Image size 2352x1568, 45° FOV — 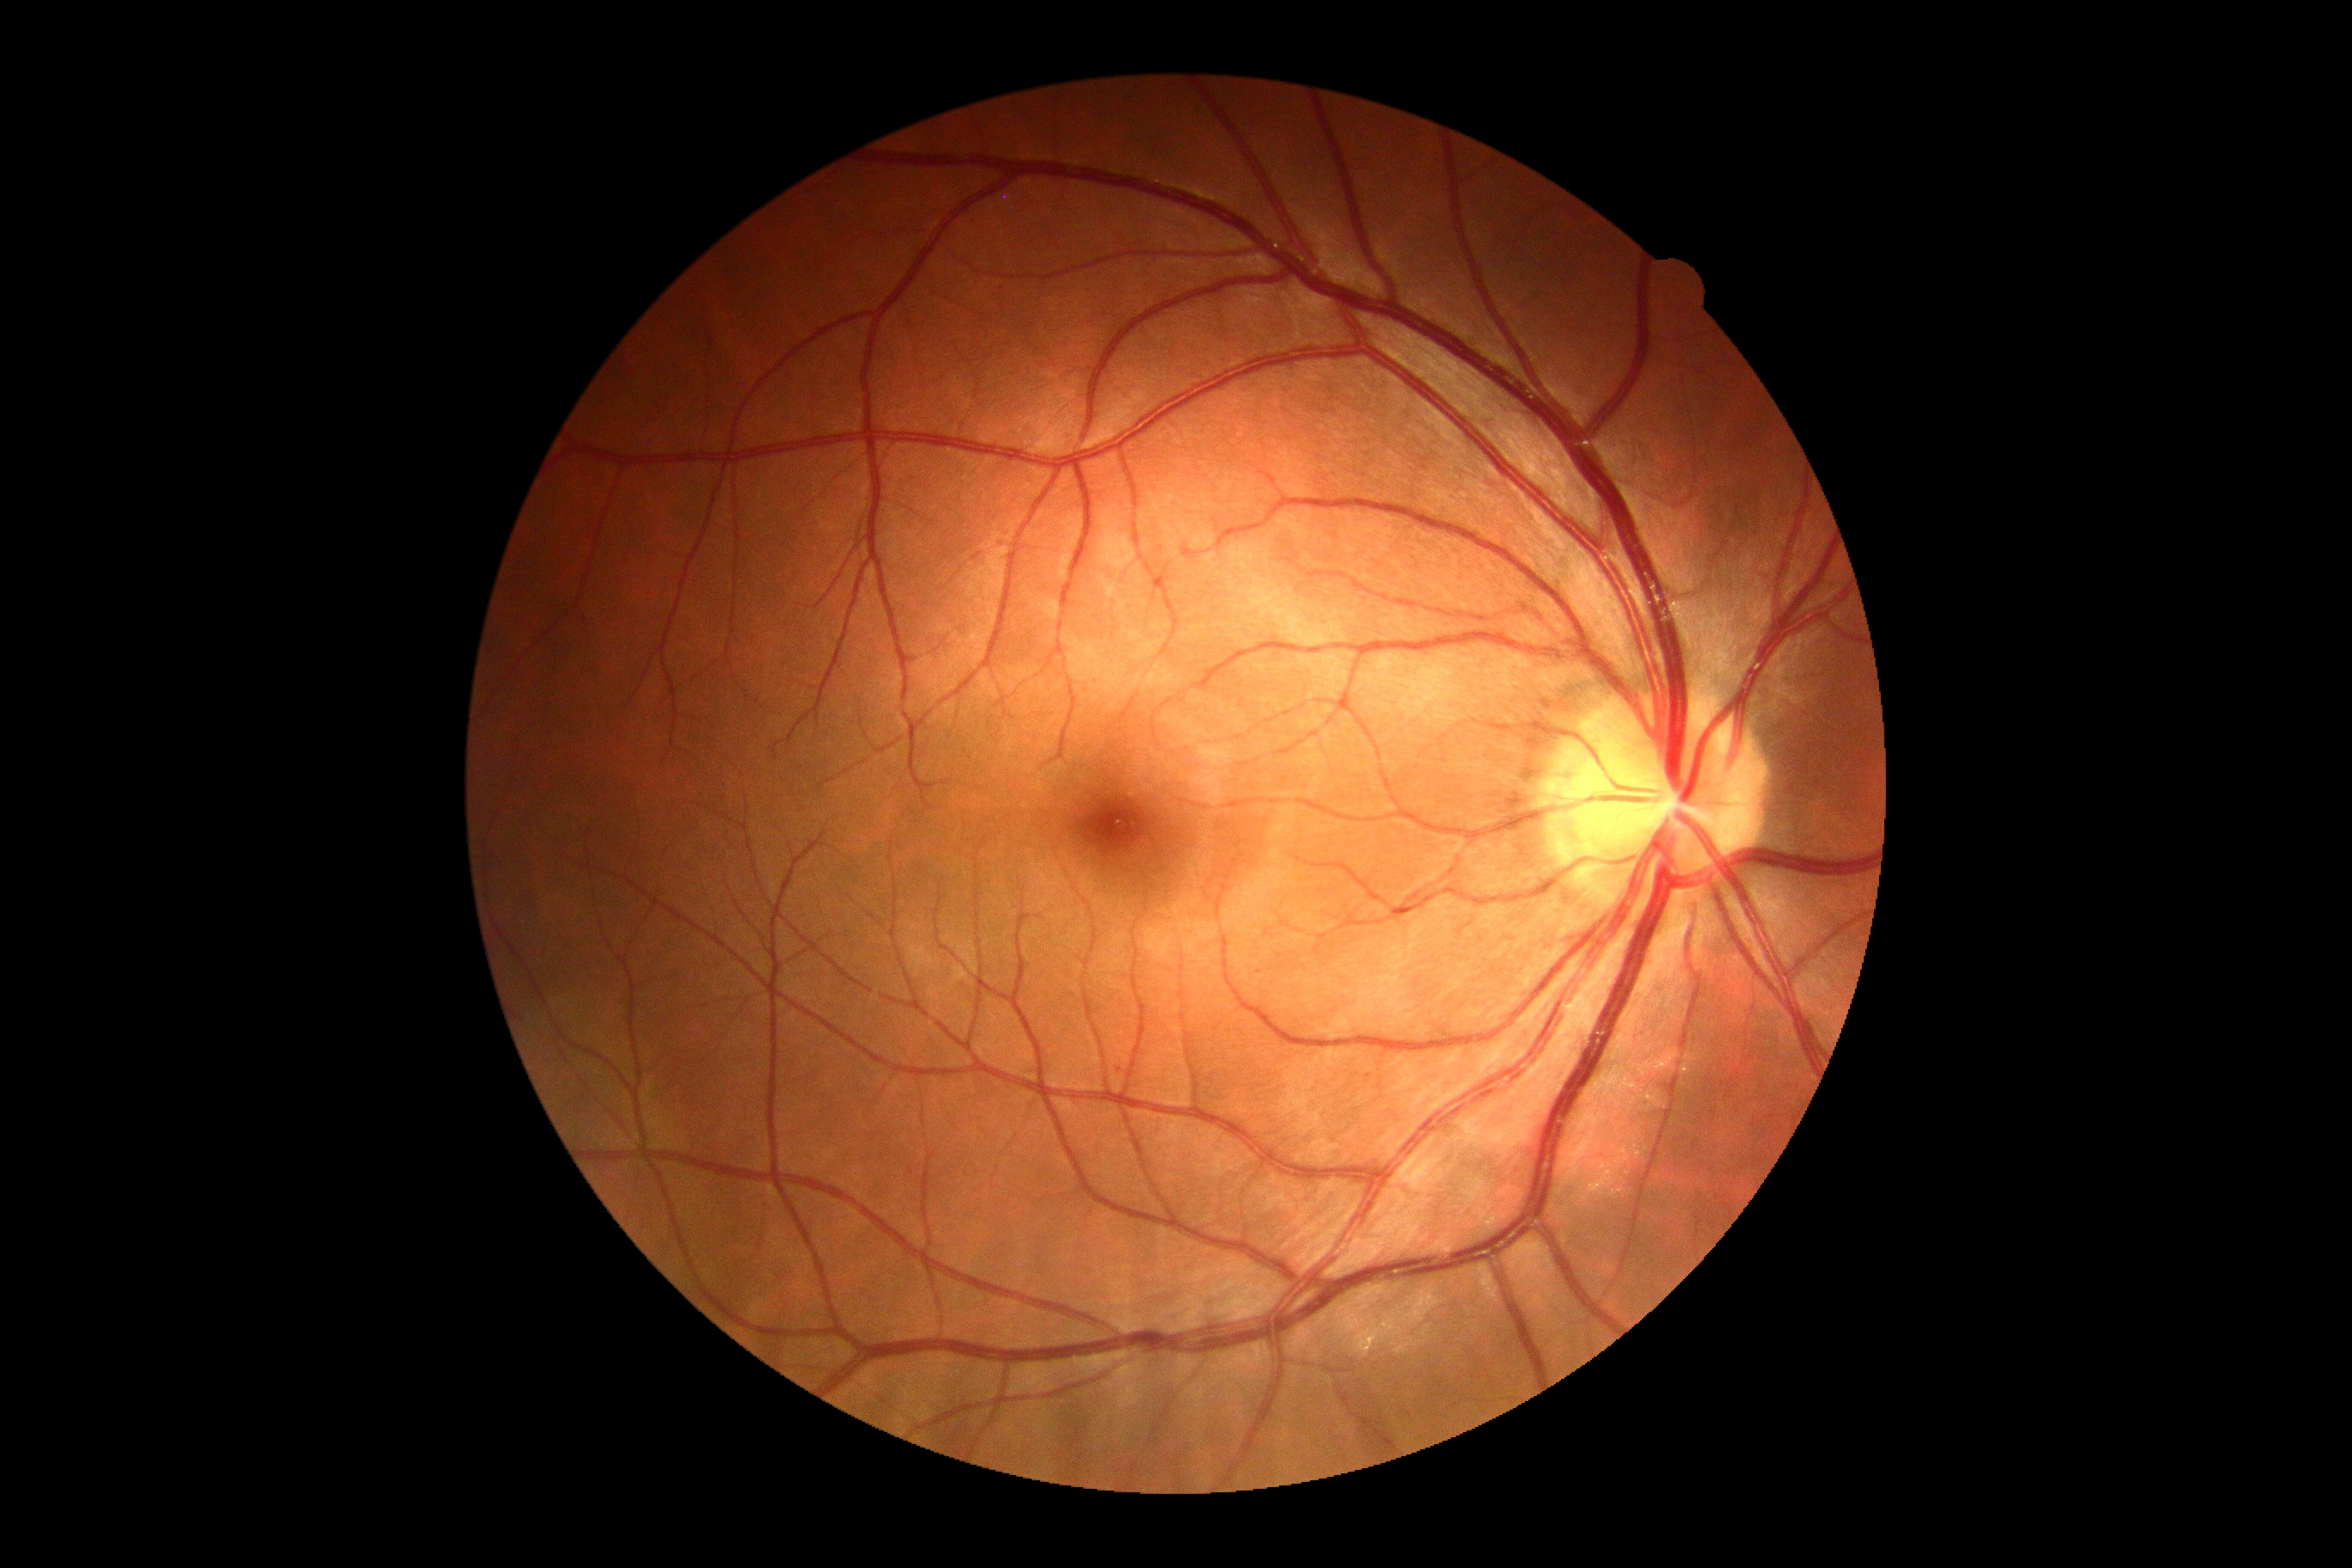 Annotations:
* DR impression: no signs of DR
* DR: grade 0 (no apparent retinopathy)